45° FOV
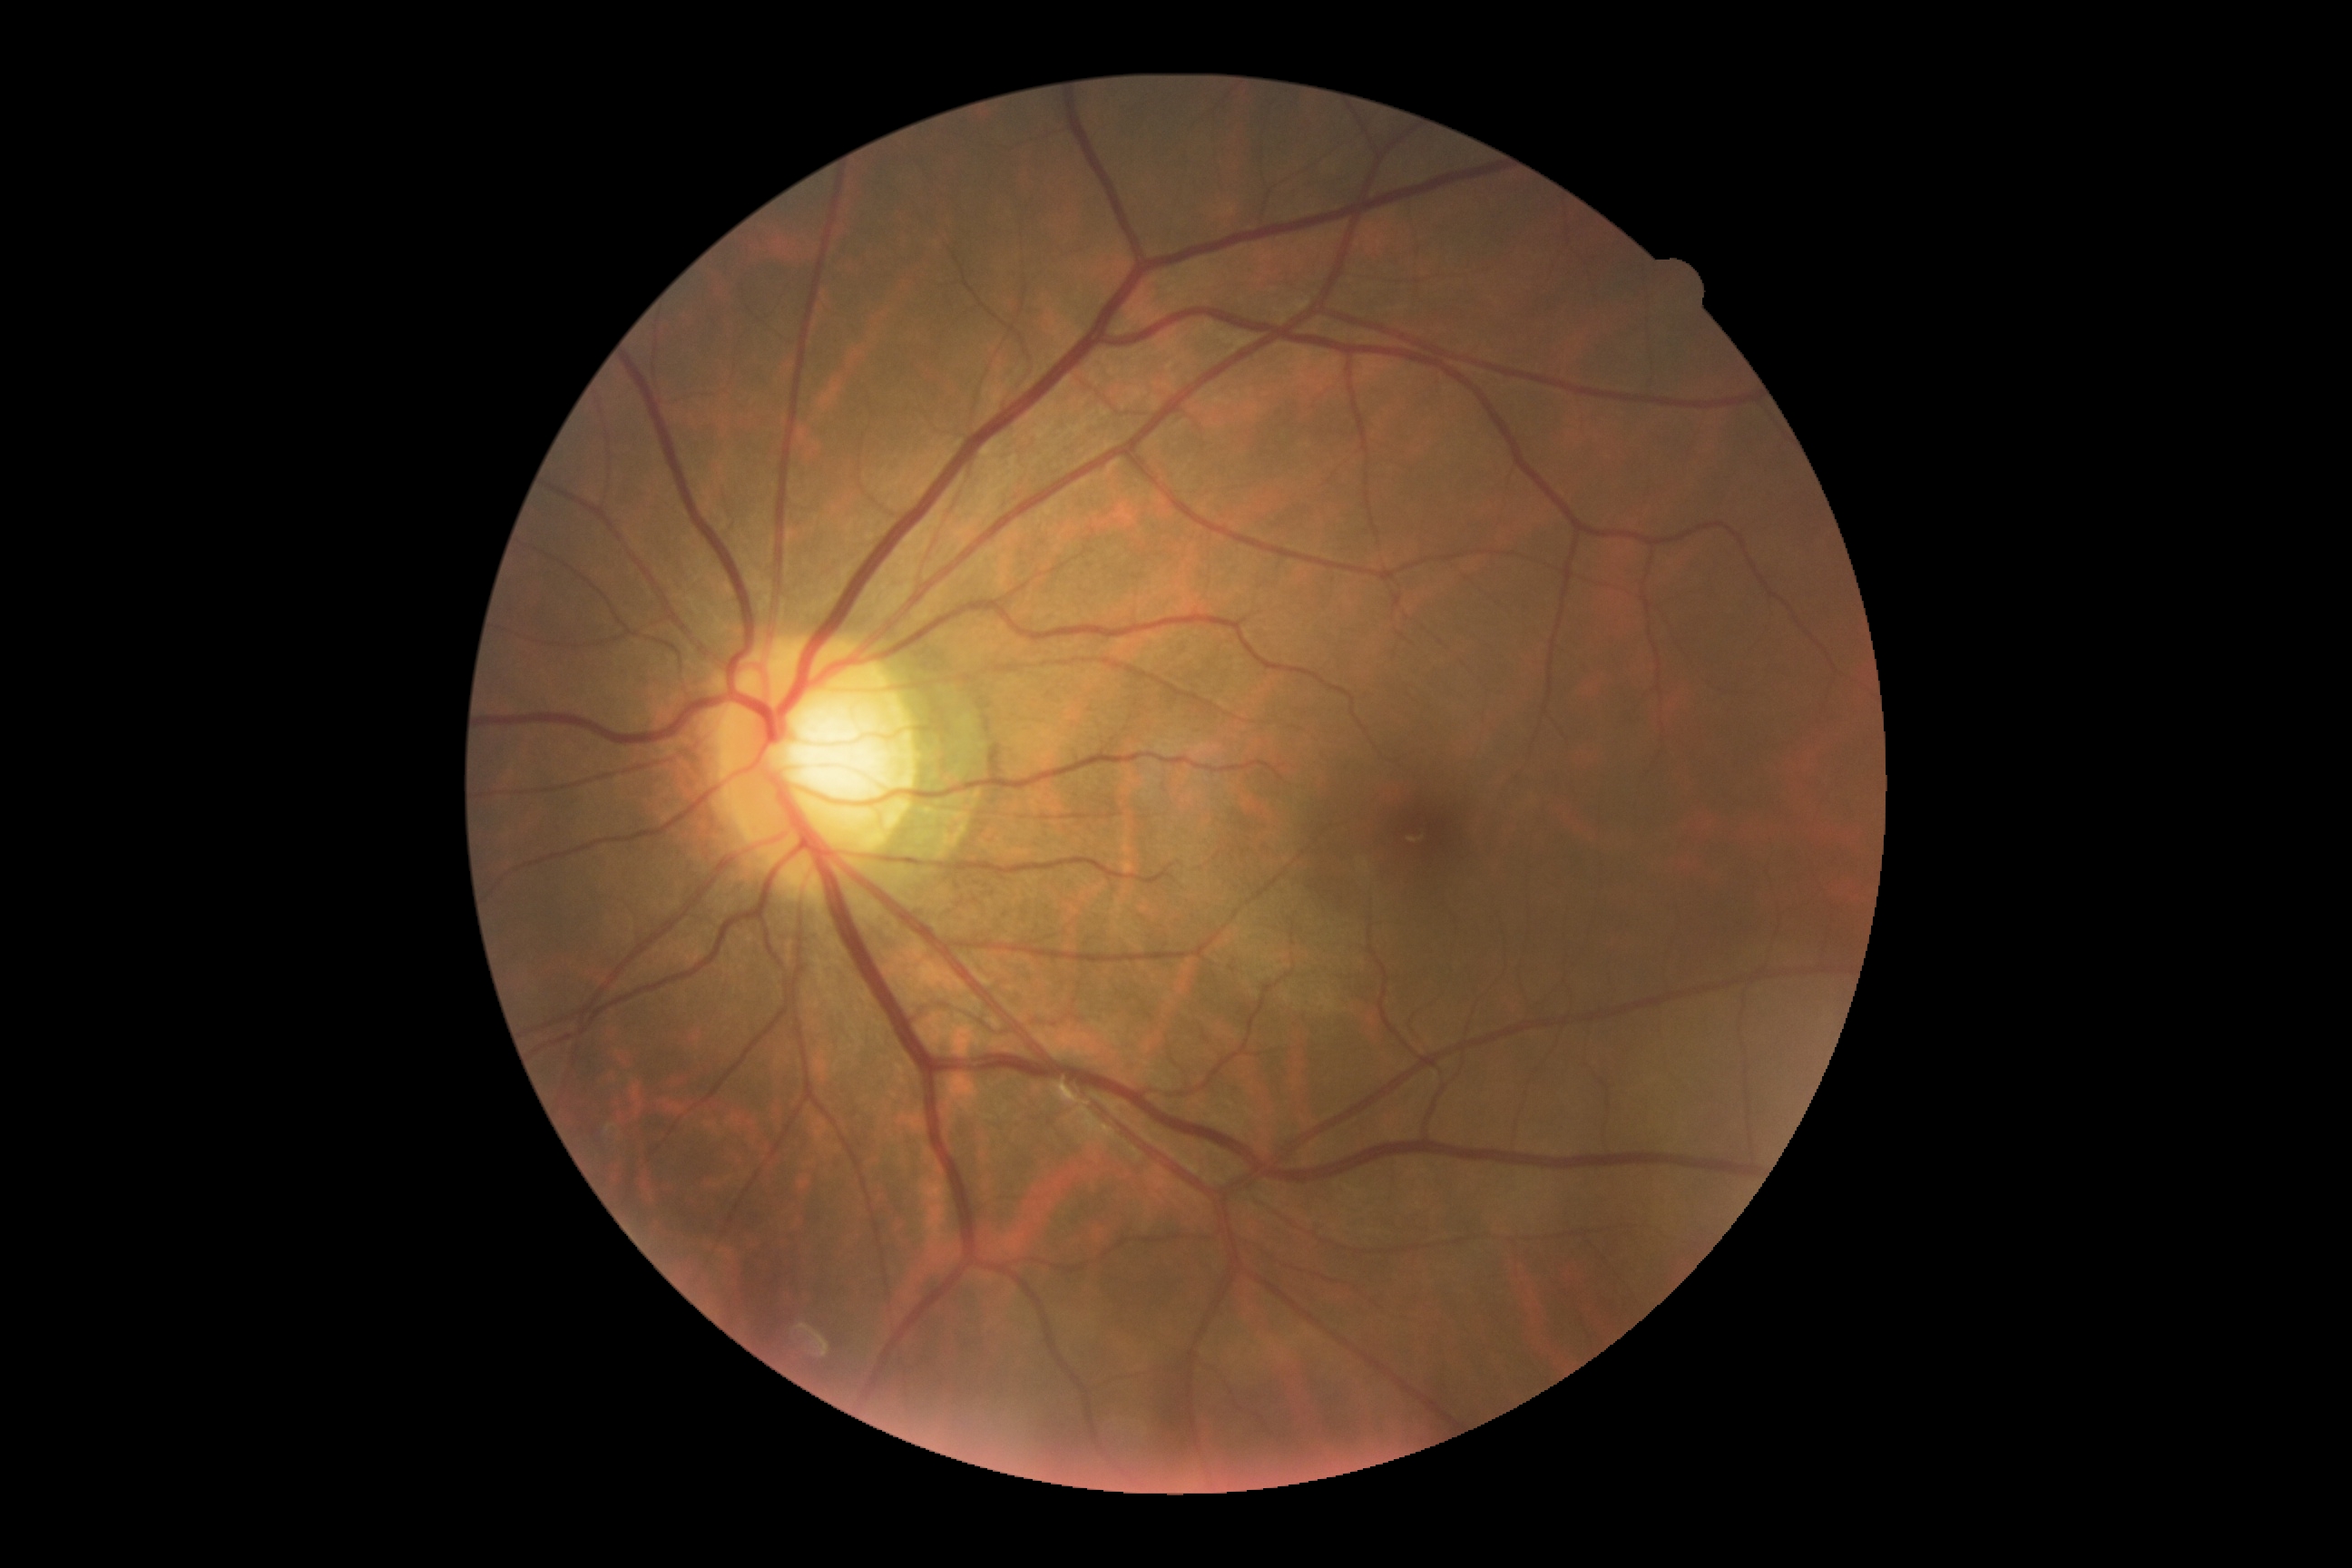
diabetic retinopathy (DR): grade 0 (no apparent retinopathy)